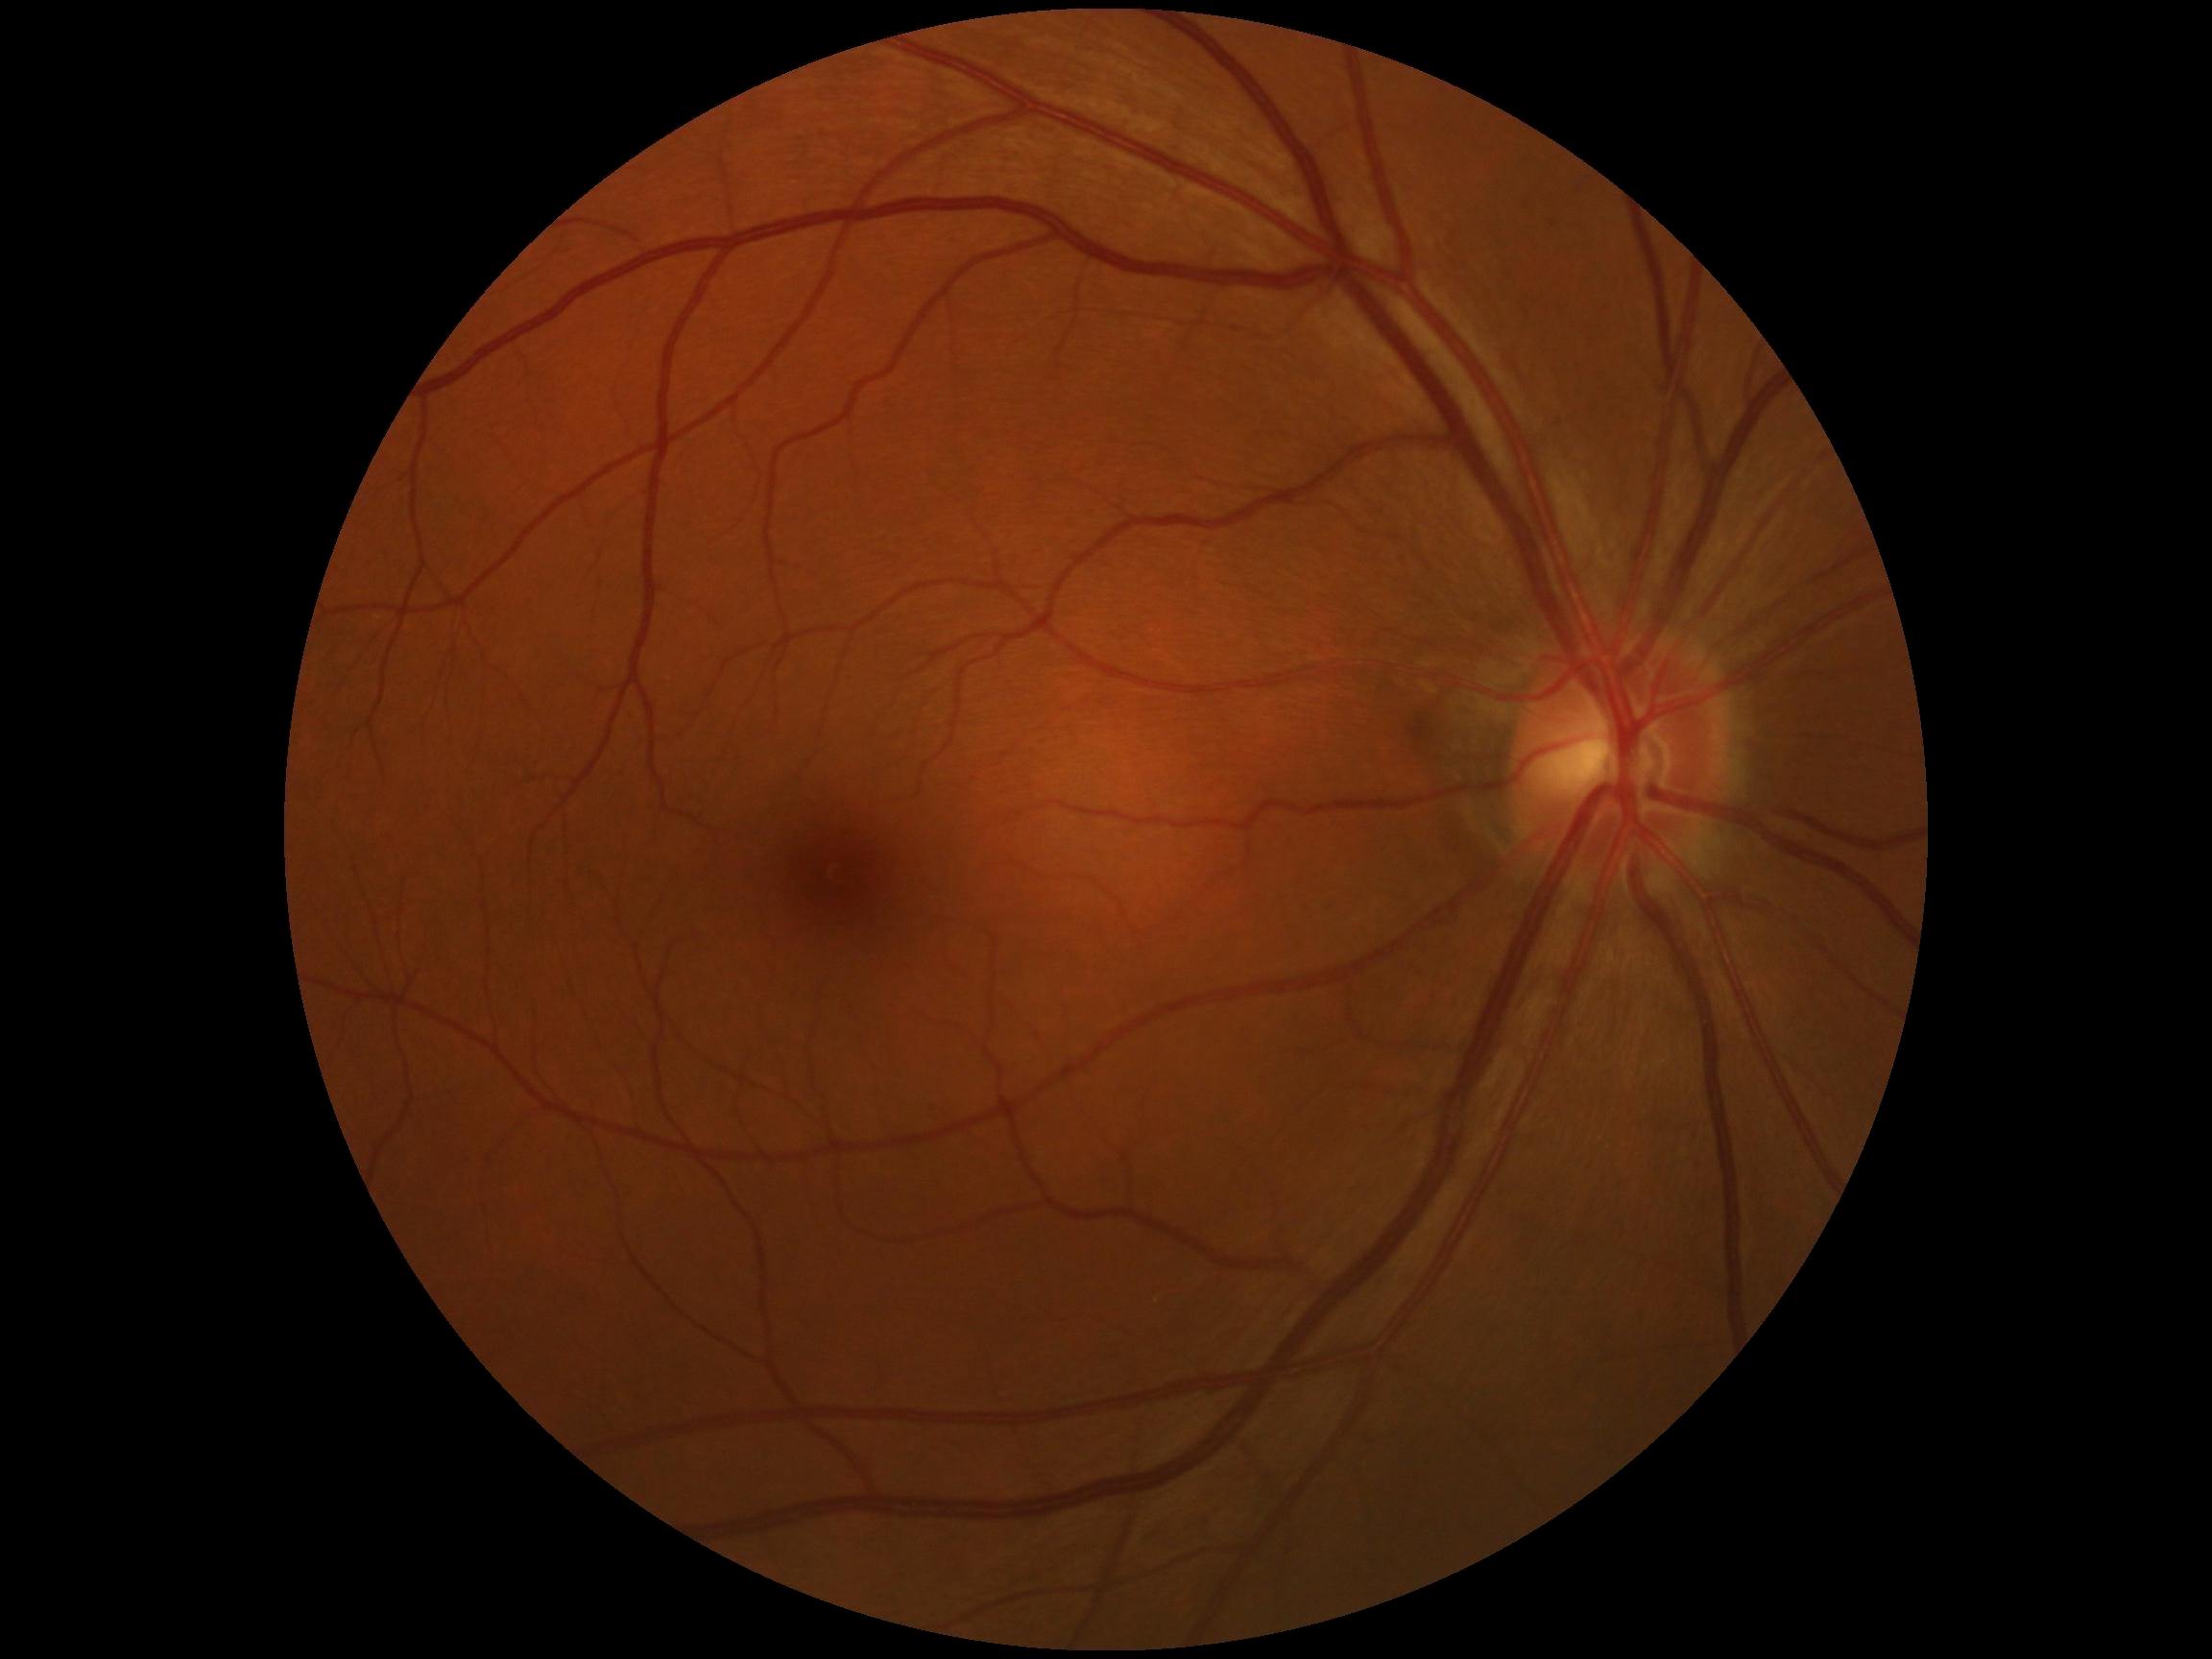

No apparent diabetic retinopathy.
DR stage: 0/4 — no visible signs of diabetic retinopathy.